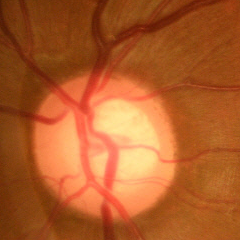

Glaucoma diagnosis = early-stage glaucoma.